2352 x 1568 pixels · FOV: 45 degrees · color fundus photograph — 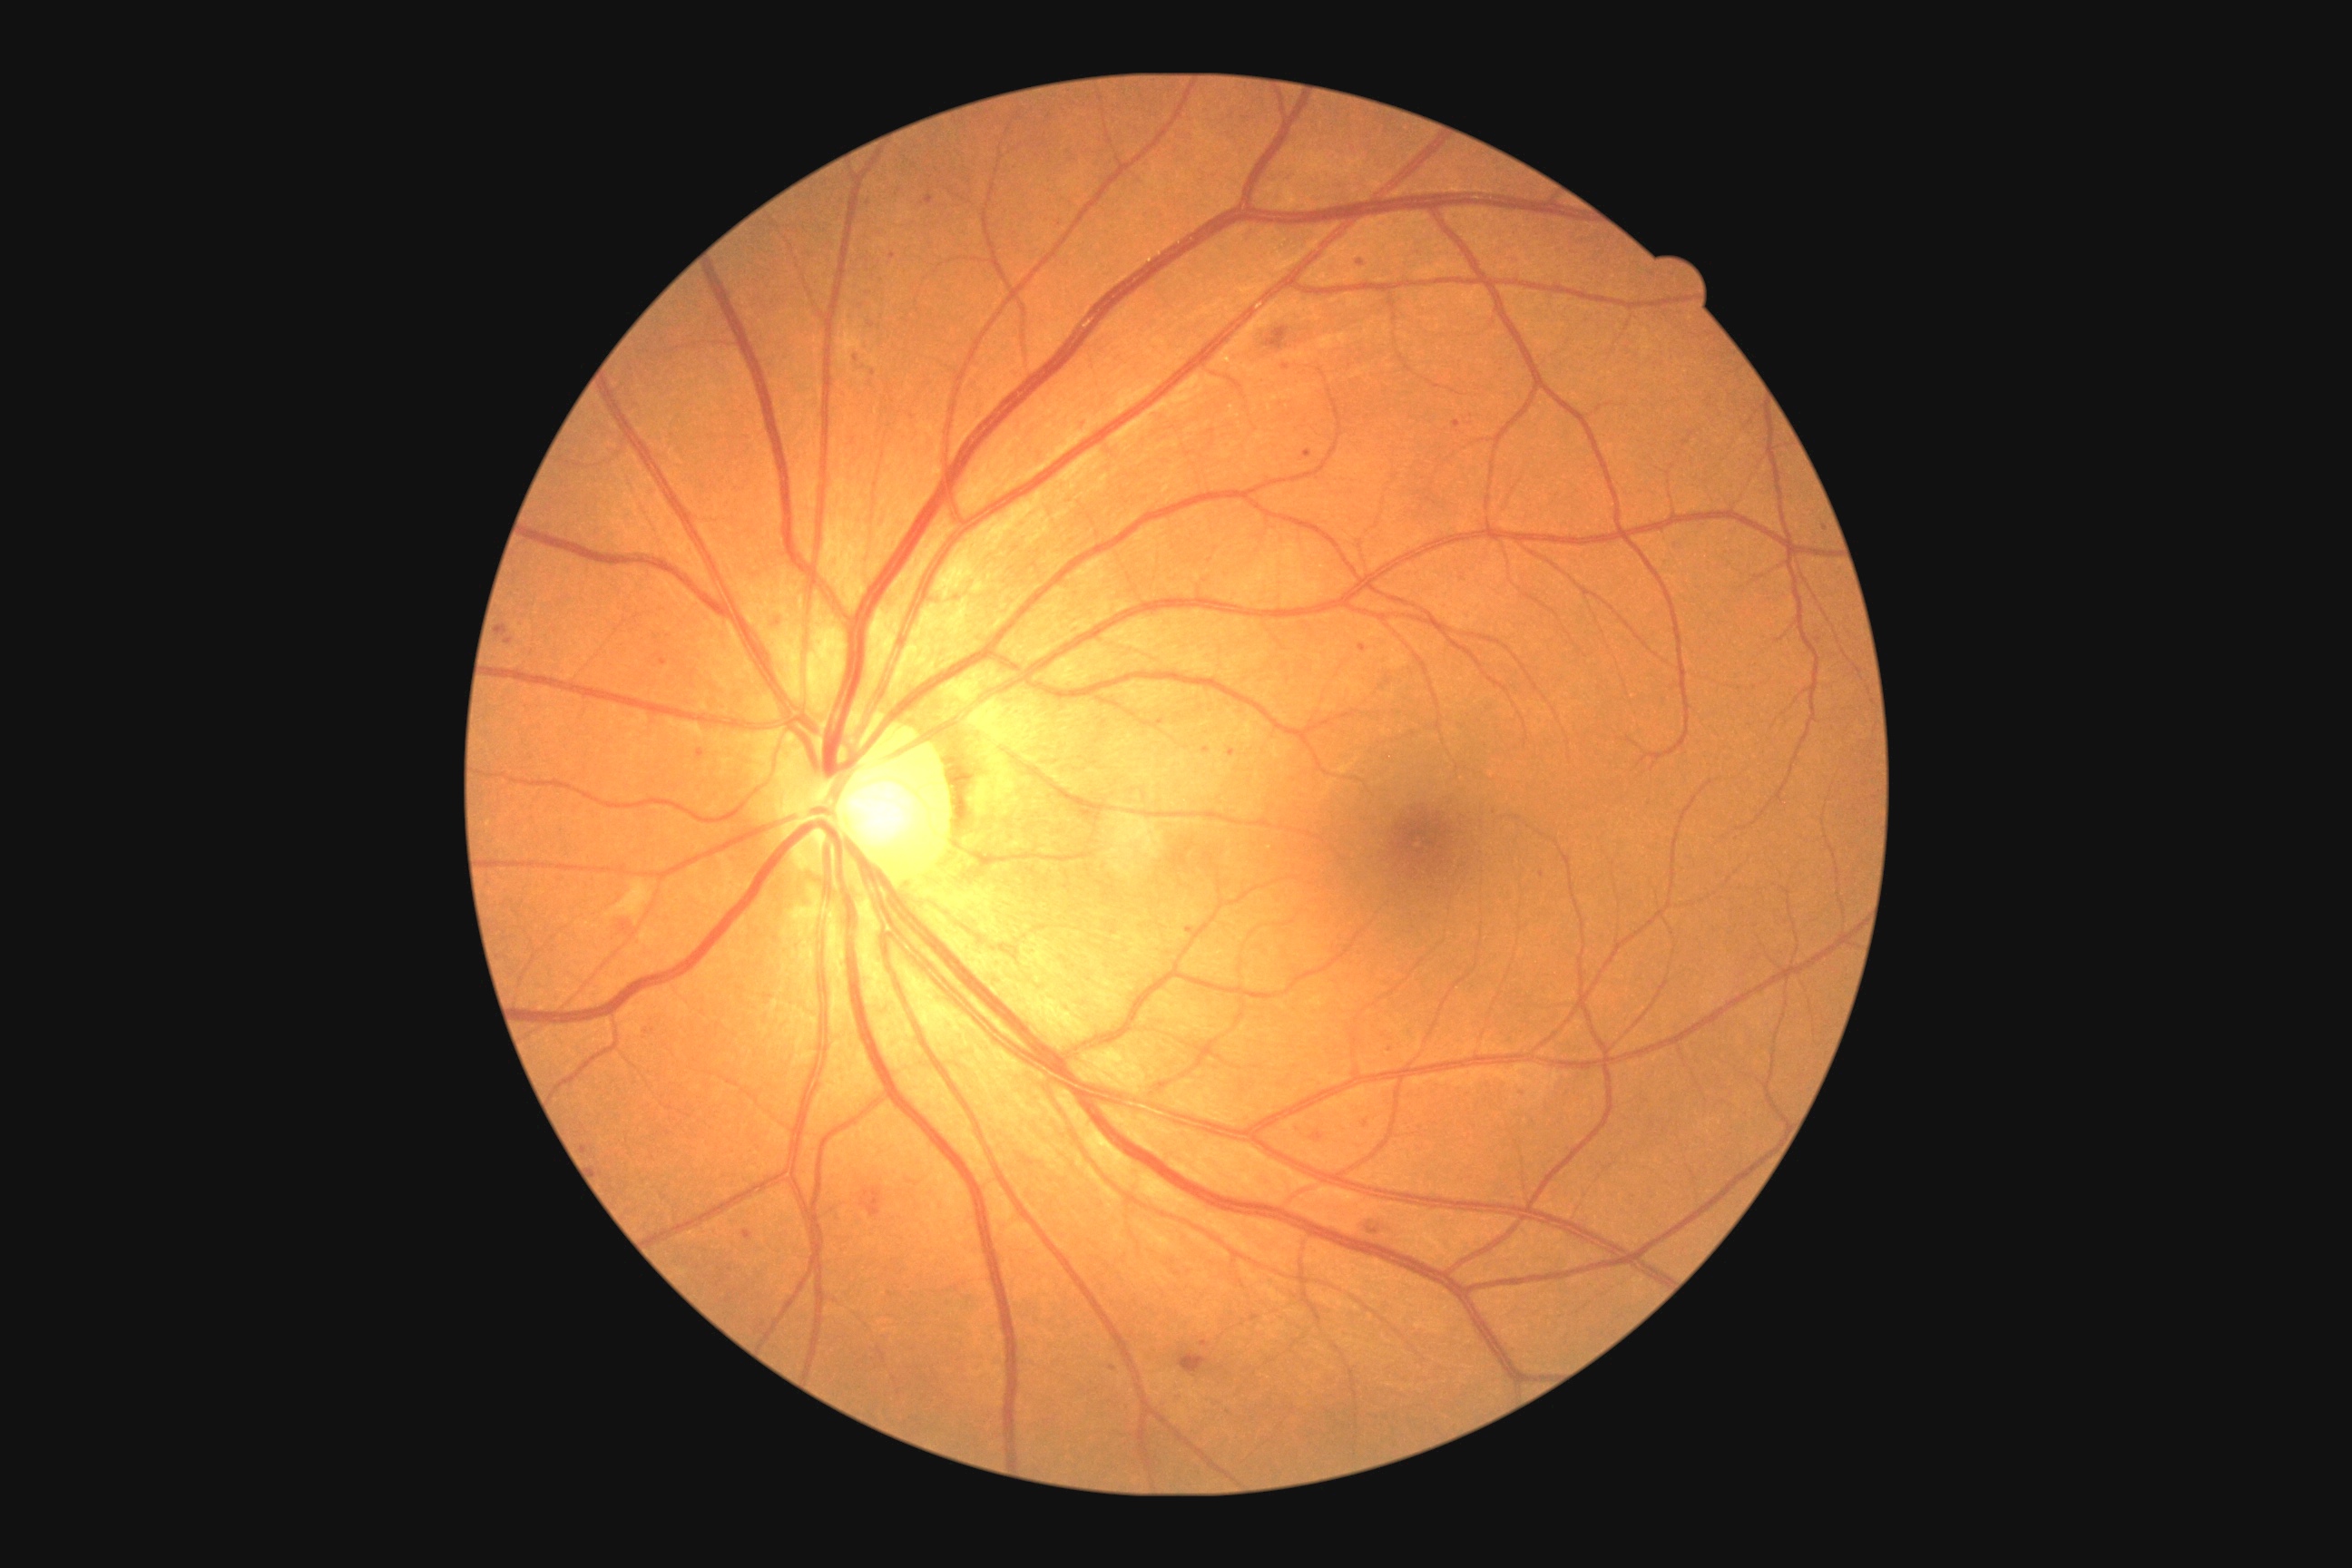
Diabetic retinopathy (DR): 2/4
Representative lesions:
soft exudates (SEs): region(605, 879, 652, 919)
hard exudates (EXs): none
hemorrhages (HEs): region(861, 1188, 883, 1217), region(1179, 1353, 1208, 1373), region(1266, 328, 1289, 351)
microaneurysms (MAs) (continued): region(1226, 750, 1237, 761), region(620, 921, 632, 934), region(1311, 1133, 1324, 1141), region(1251, 1315, 1259, 1320), region(1520, 1086, 1525, 1099), region(1455, 420, 1462, 429), region(1188, 925, 1195, 934), region(743, 1231, 752, 1240), region(1360, 1224, 1389, 1242), region(1304, 449, 1313, 458)
Small MAs near [x=1366, y=1124], [x=893, y=256], [x=873, y=374], [x=659, y=656], [x=1112, y=1367], [x=585, y=1149], [x=1361, y=263]